Pediatric wide-field fundus photograph; captured with the Clarity RetCam 3 (130° field of view): 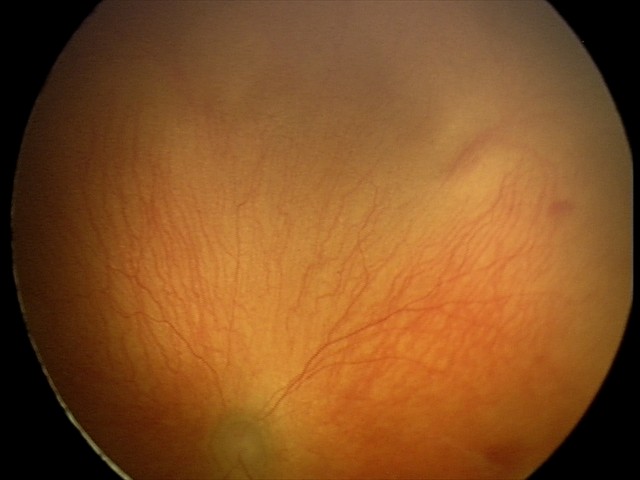

Diagnosis from this screening exam: aggressive retinopathy of prematurity (A-ROP).
Plus disease present.